45° field of view · CFP · 2352x1568.
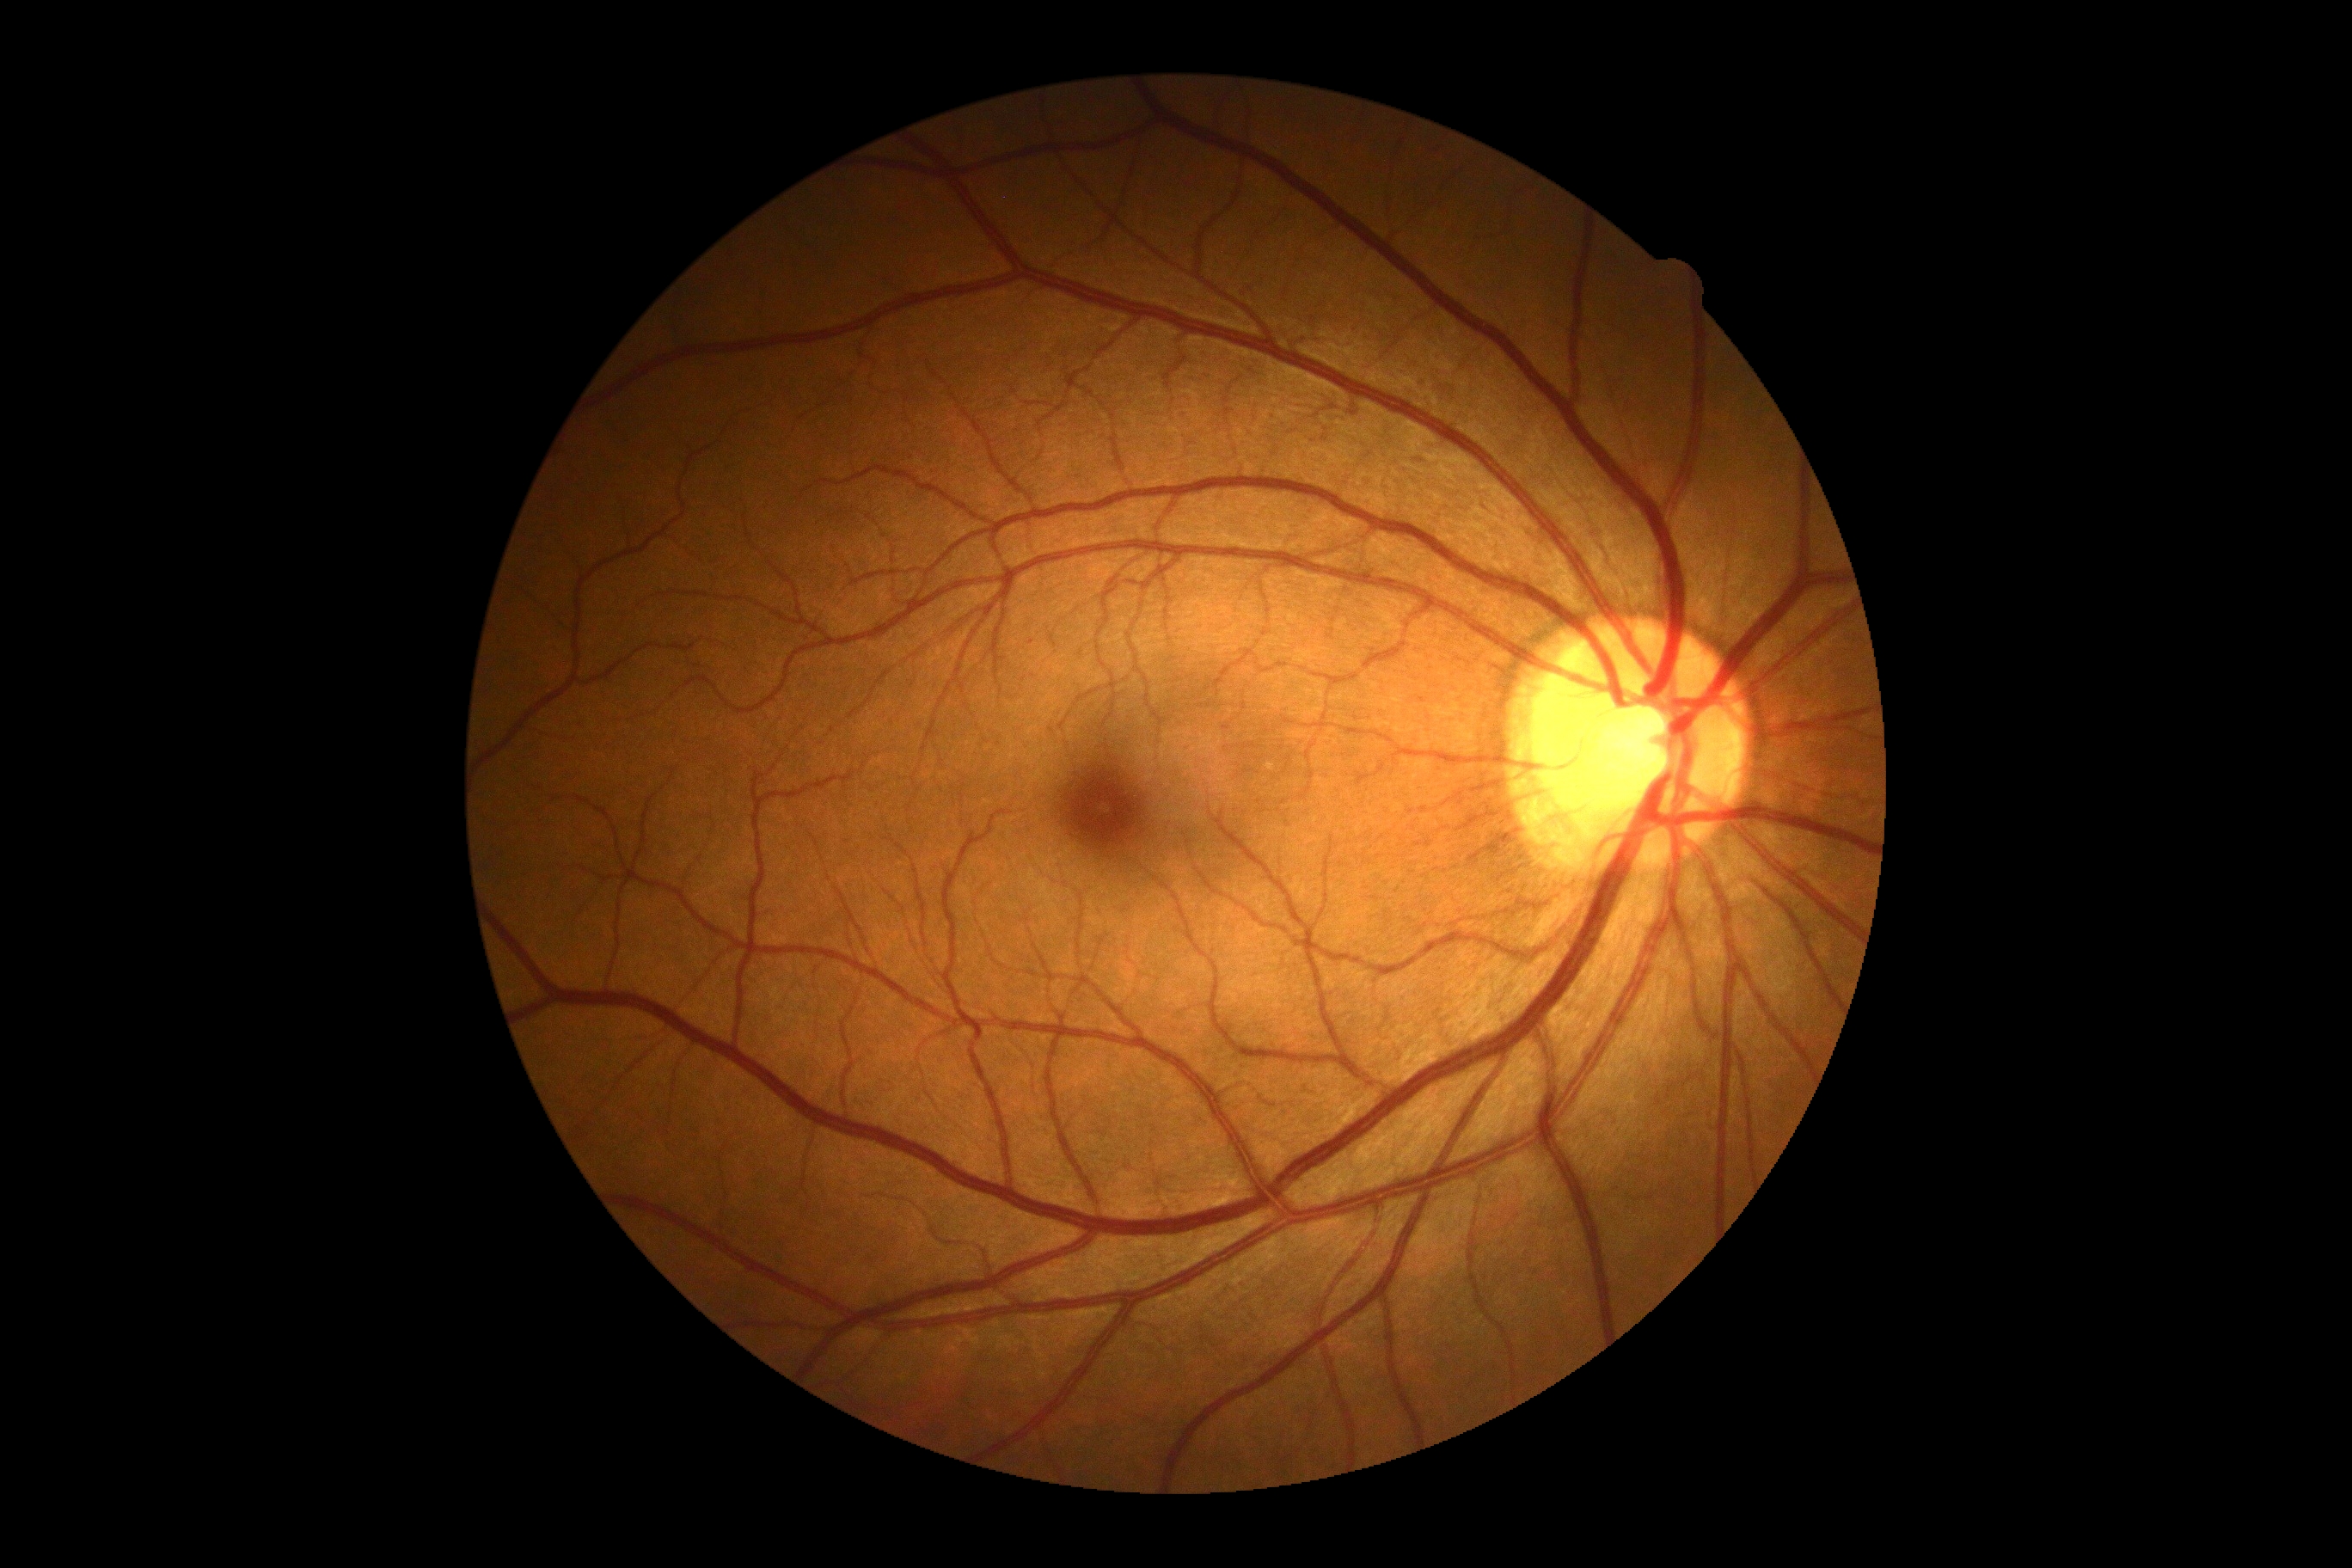 Diabetic retinopathy (DR): grade 0 (no apparent retinopathy).